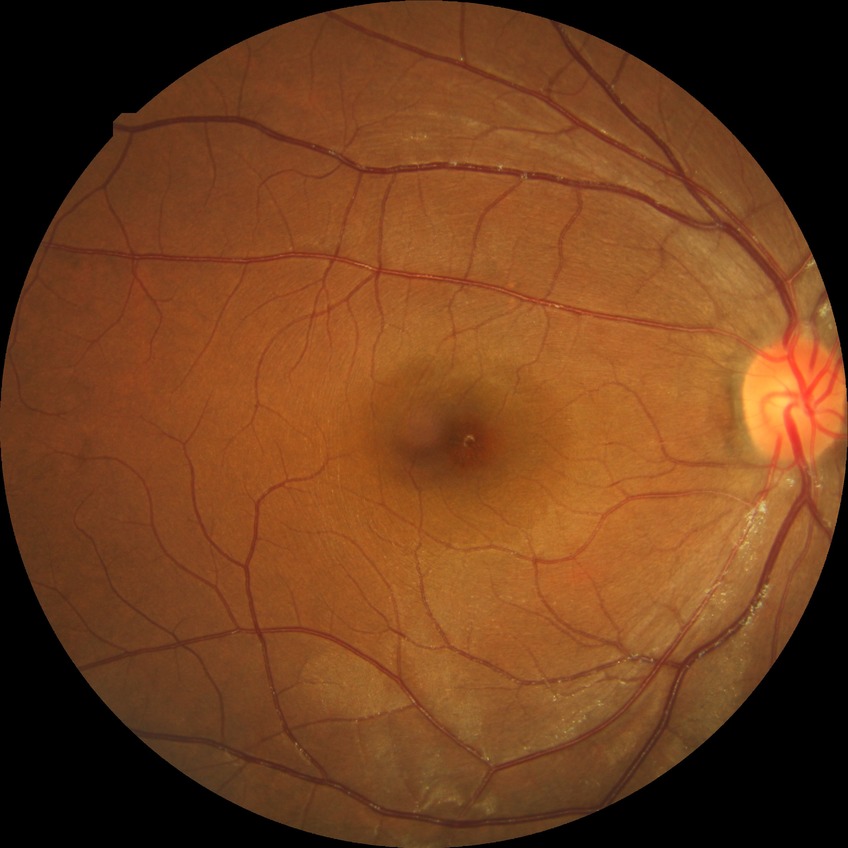
Retinopathy stage: no diabetic retinopathy.